Wide-field fundus image from infant ROP screening · 1240 x 1240 pixels · 100° field of view (Phoenix ICON)
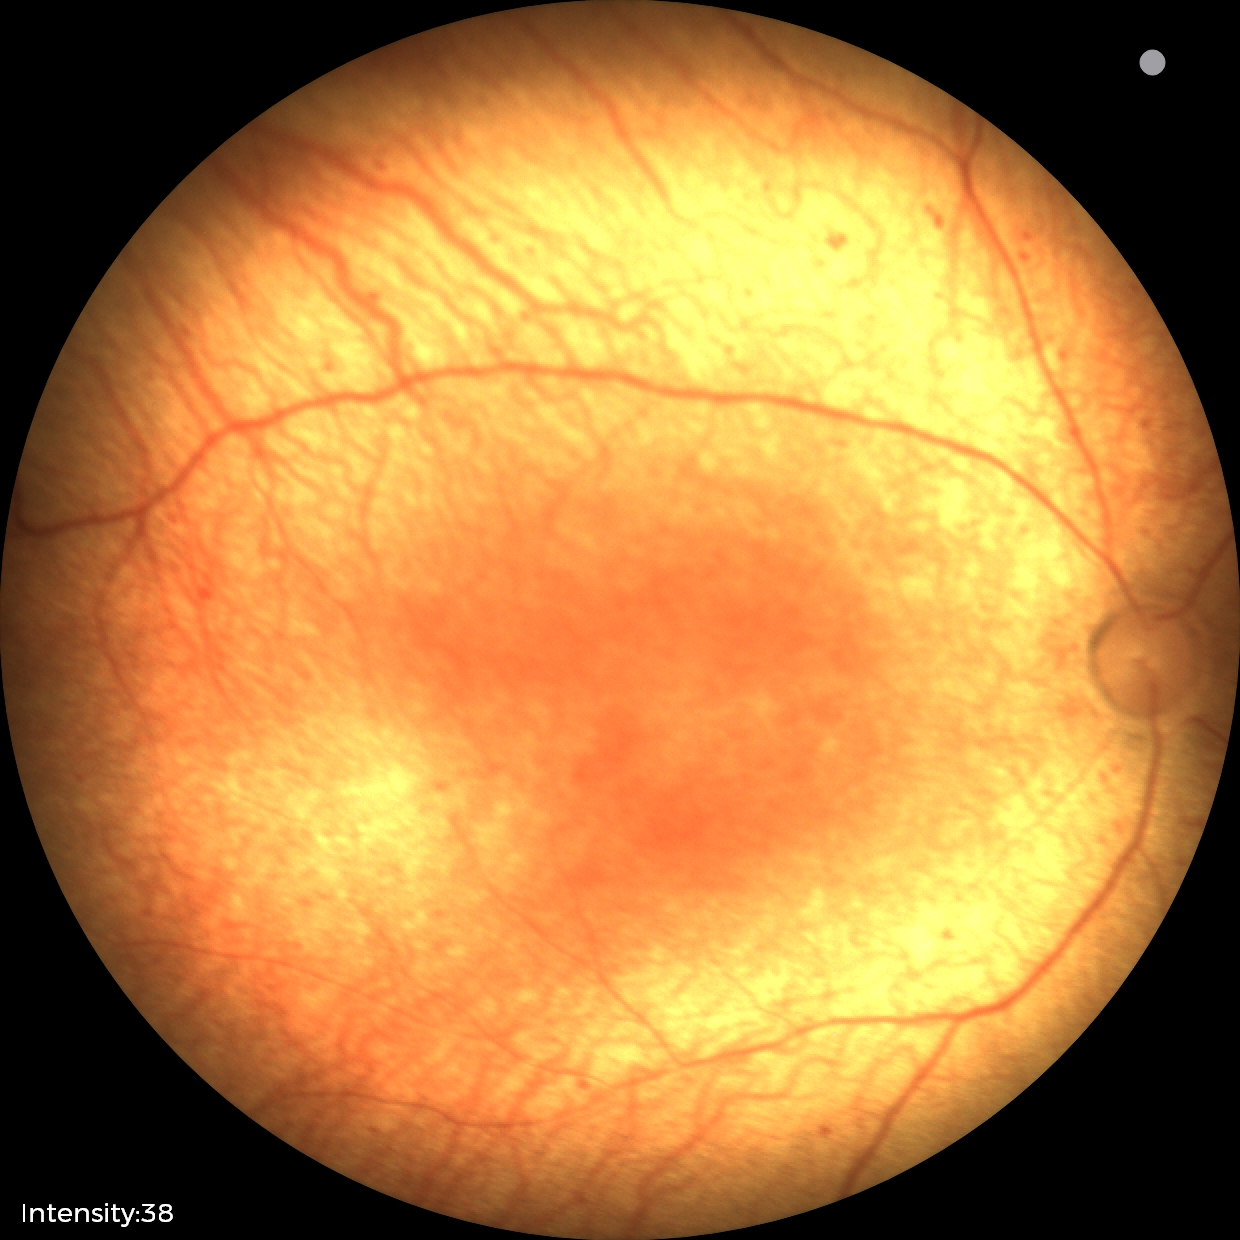
Diagnosis from this screening exam: status post ROP — retinal appearance after treated retinopathy of prematurity. Plus disease absent.